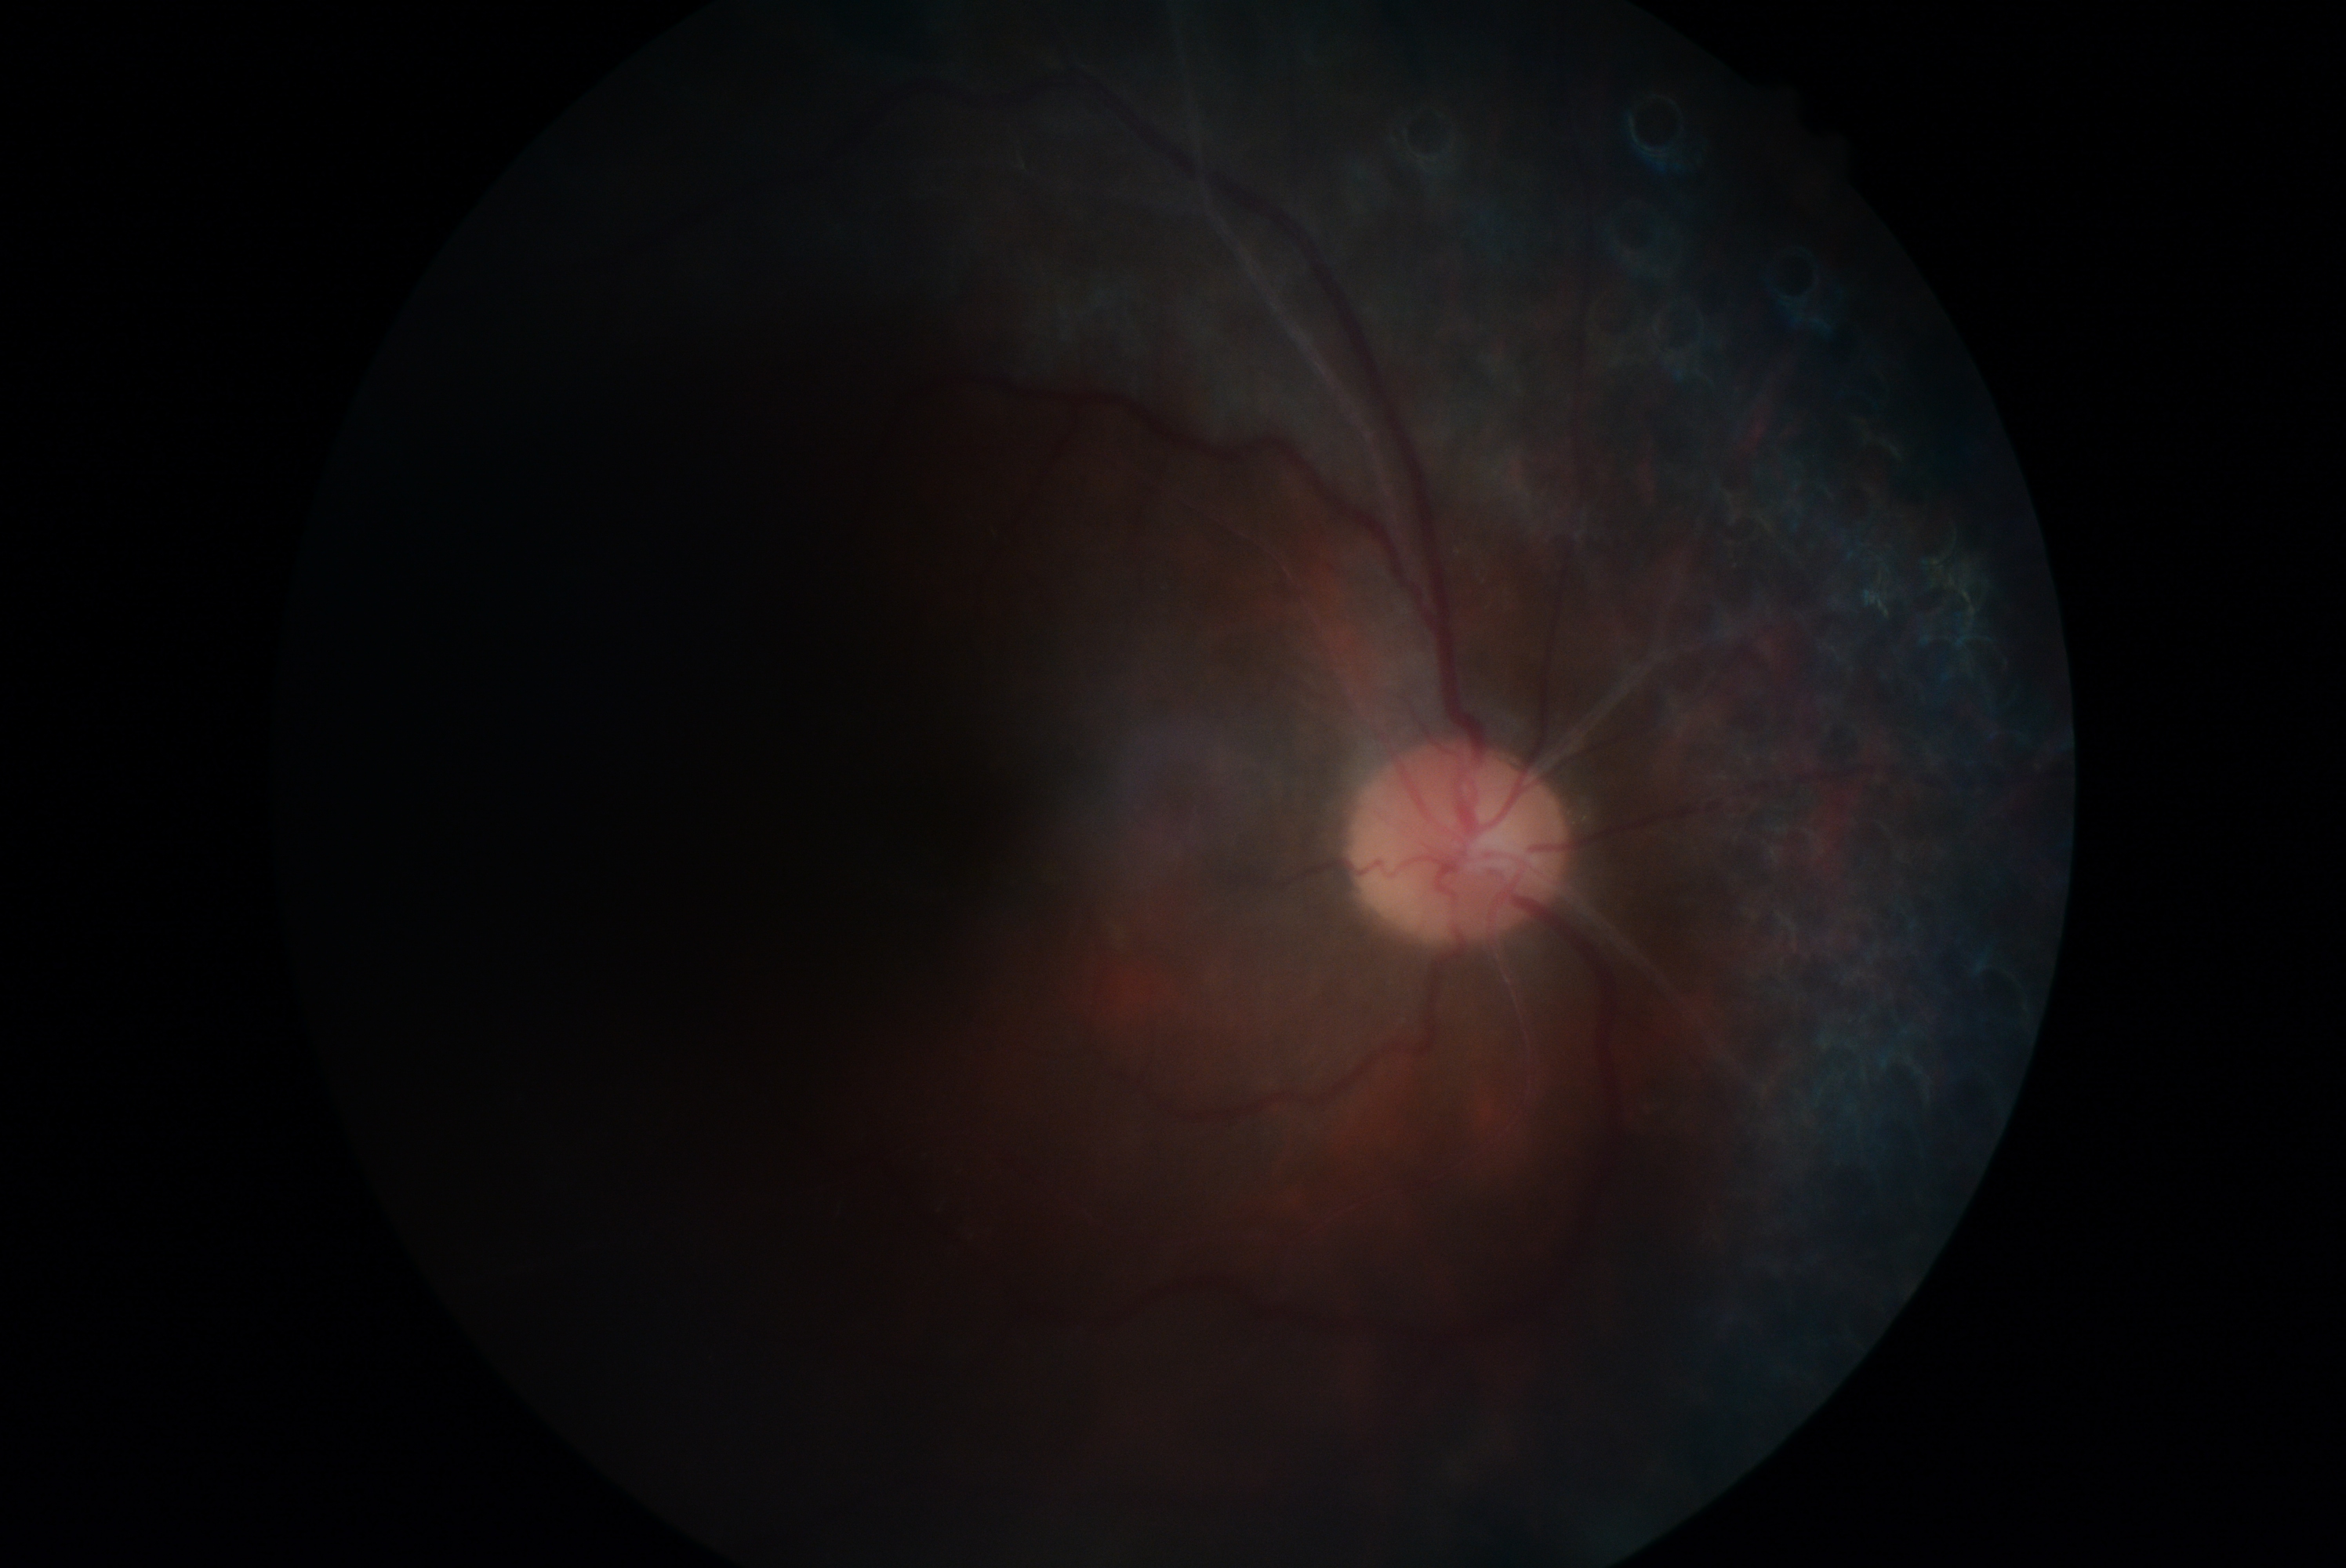
retinopathy=ungradable.